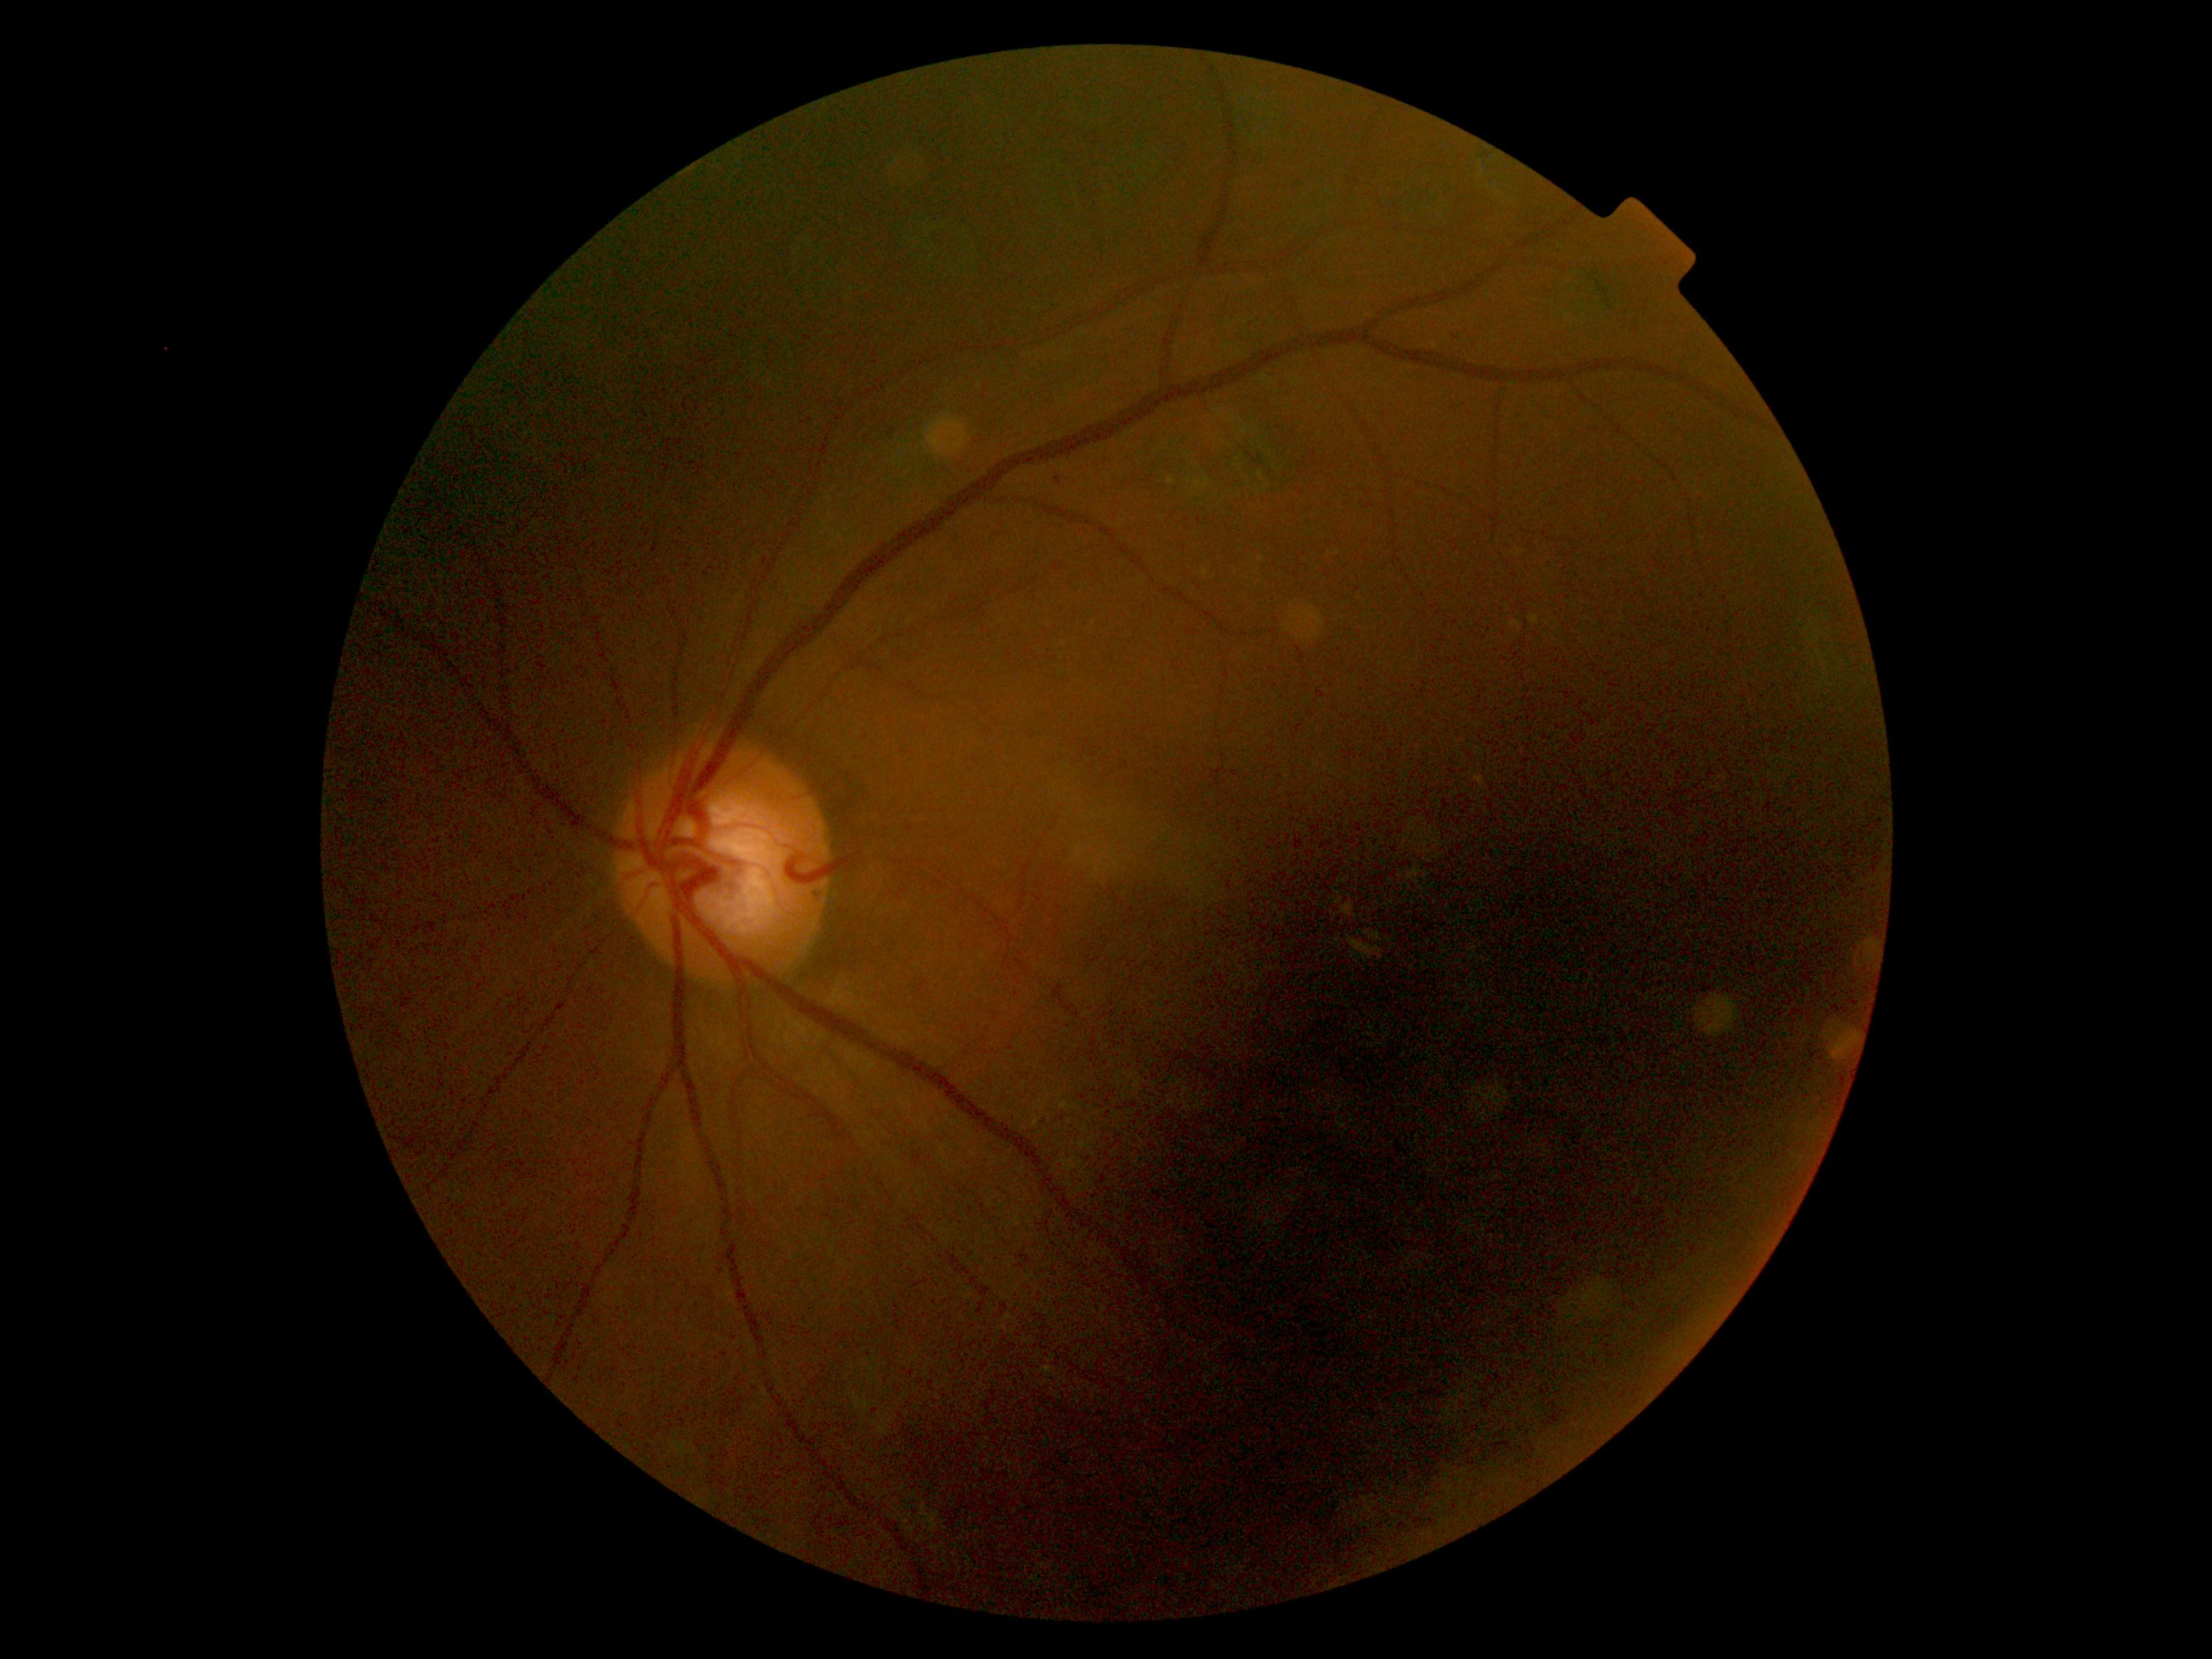

DR stage is moderate non-proliferative diabetic retinopathy (grade 2) — more than just microaneurysms but less than severe NPDR.